Image size 2352x1568:
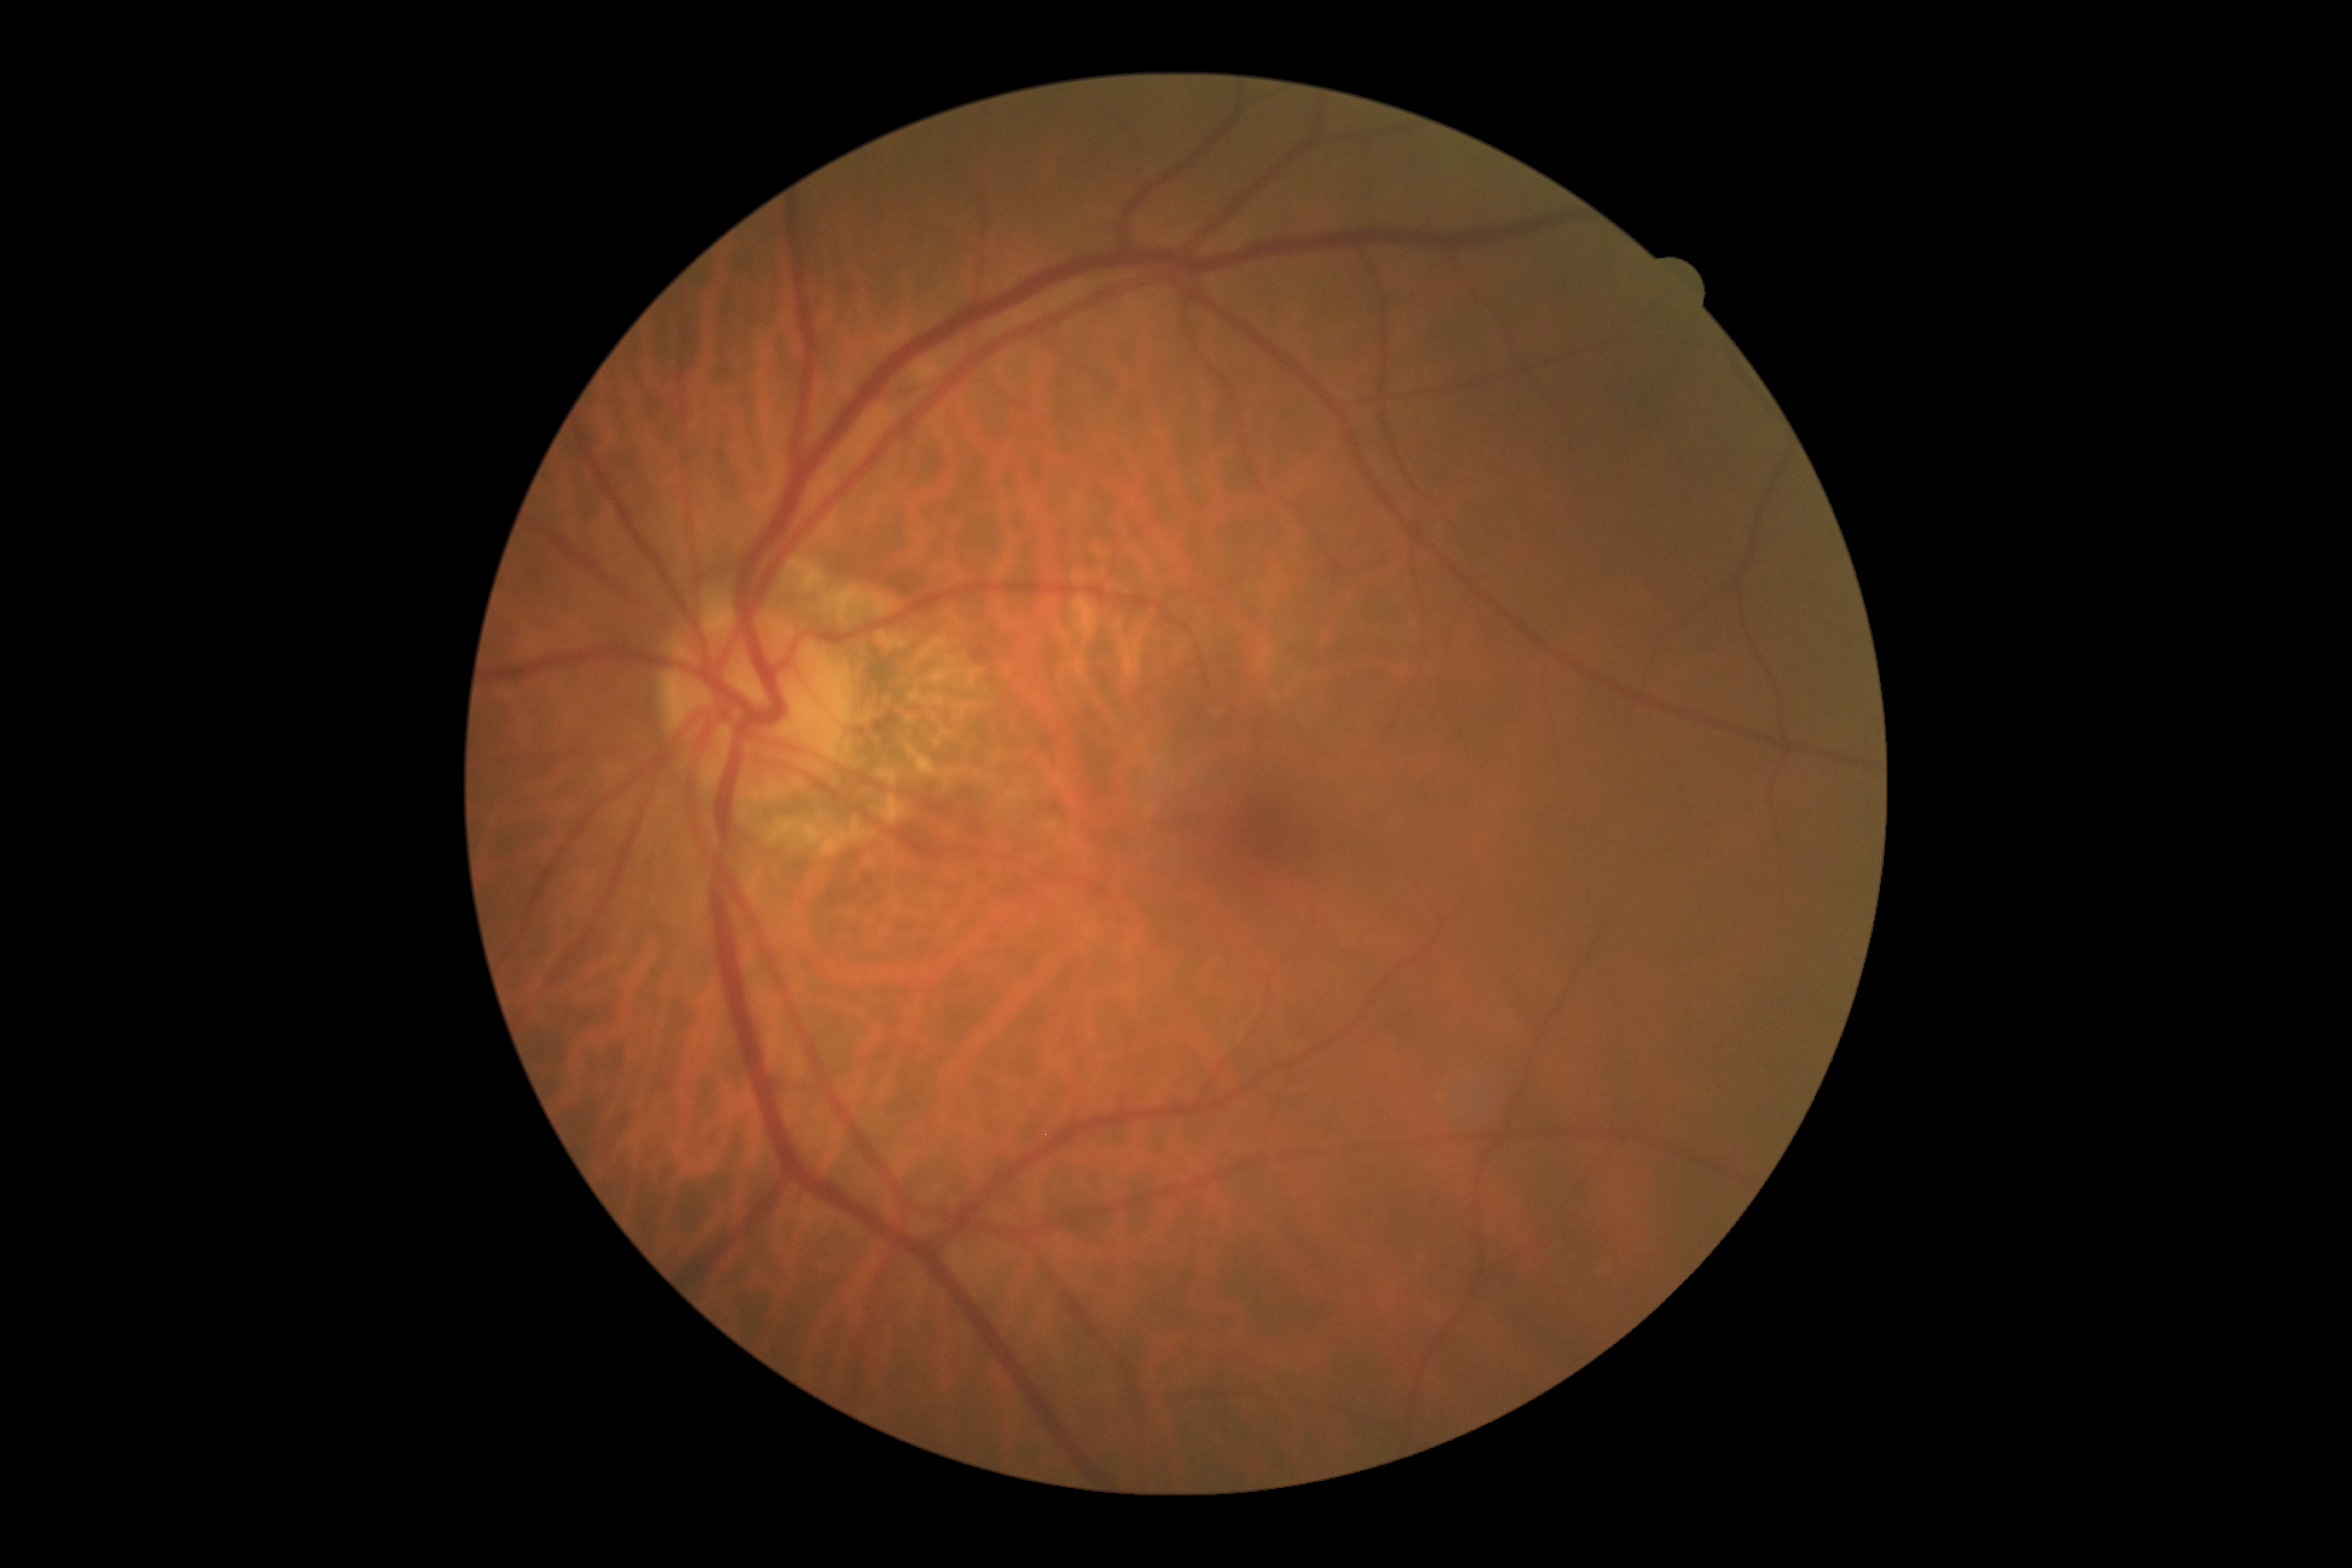

Diabetic retinopathy (DR): grade 0 (no apparent retinopathy).